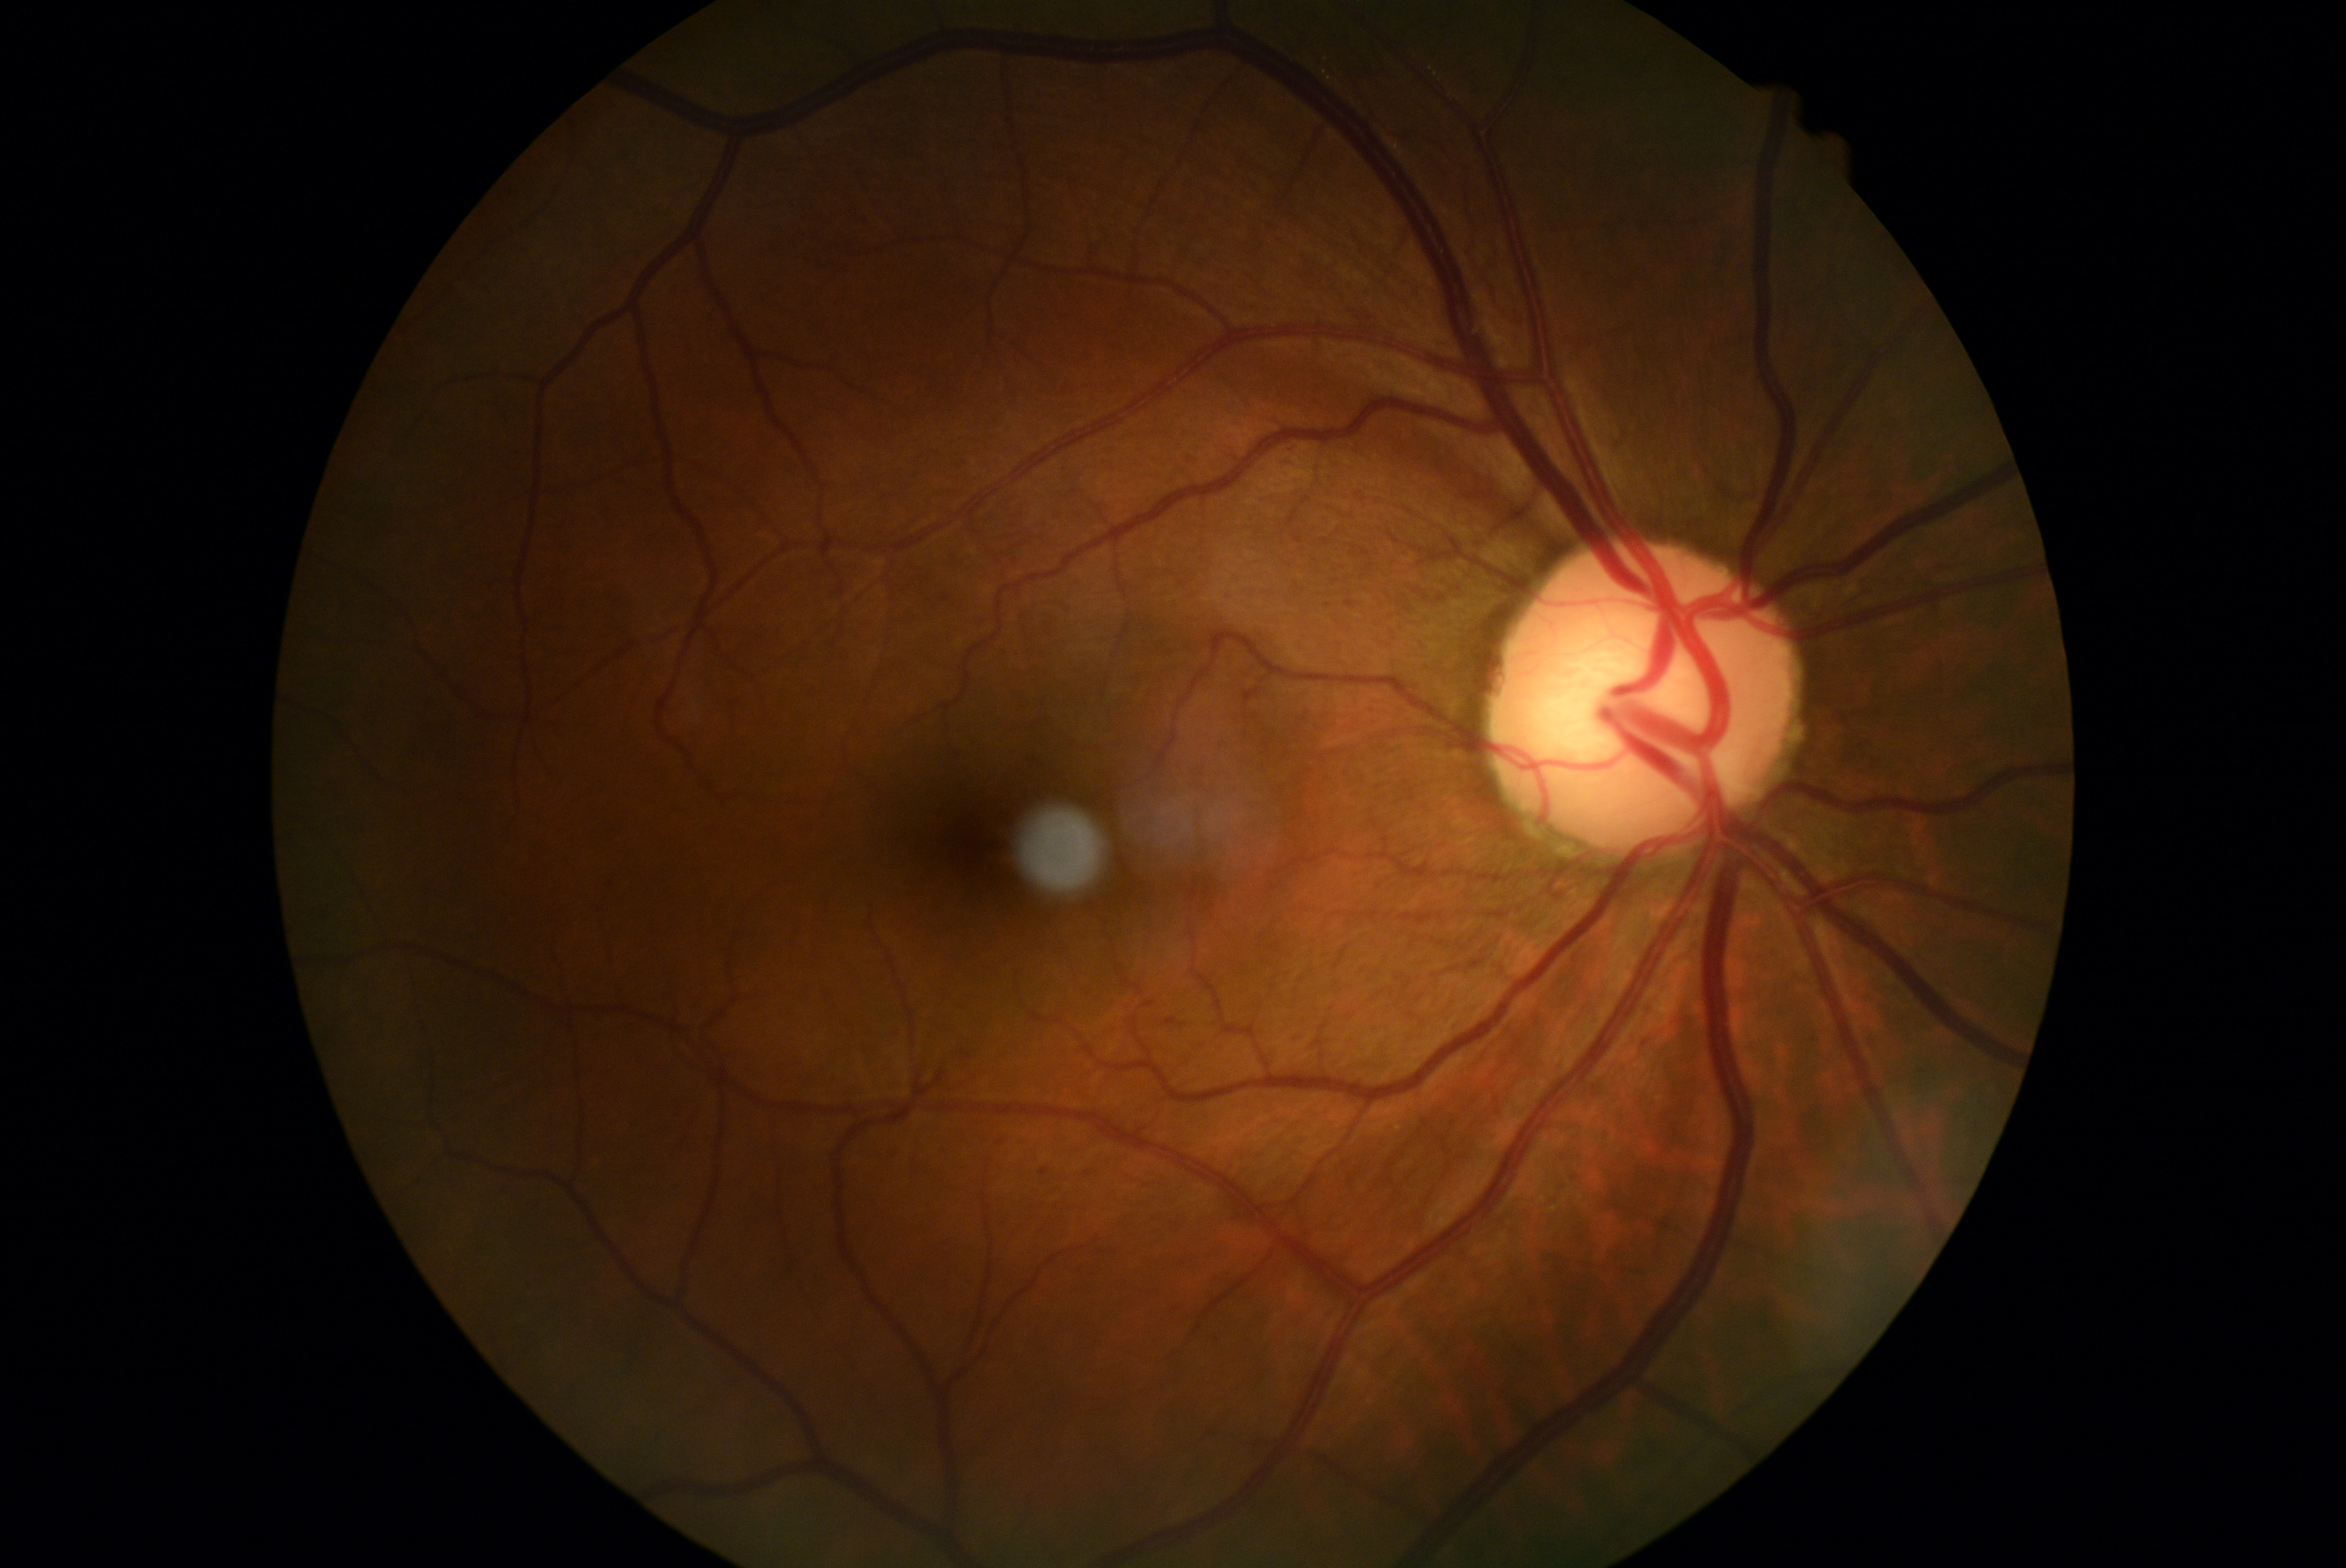 Diabetic retinopathy (DR): grade 0 (no apparent retinopathy).